Fundus photo, 45° FOV: 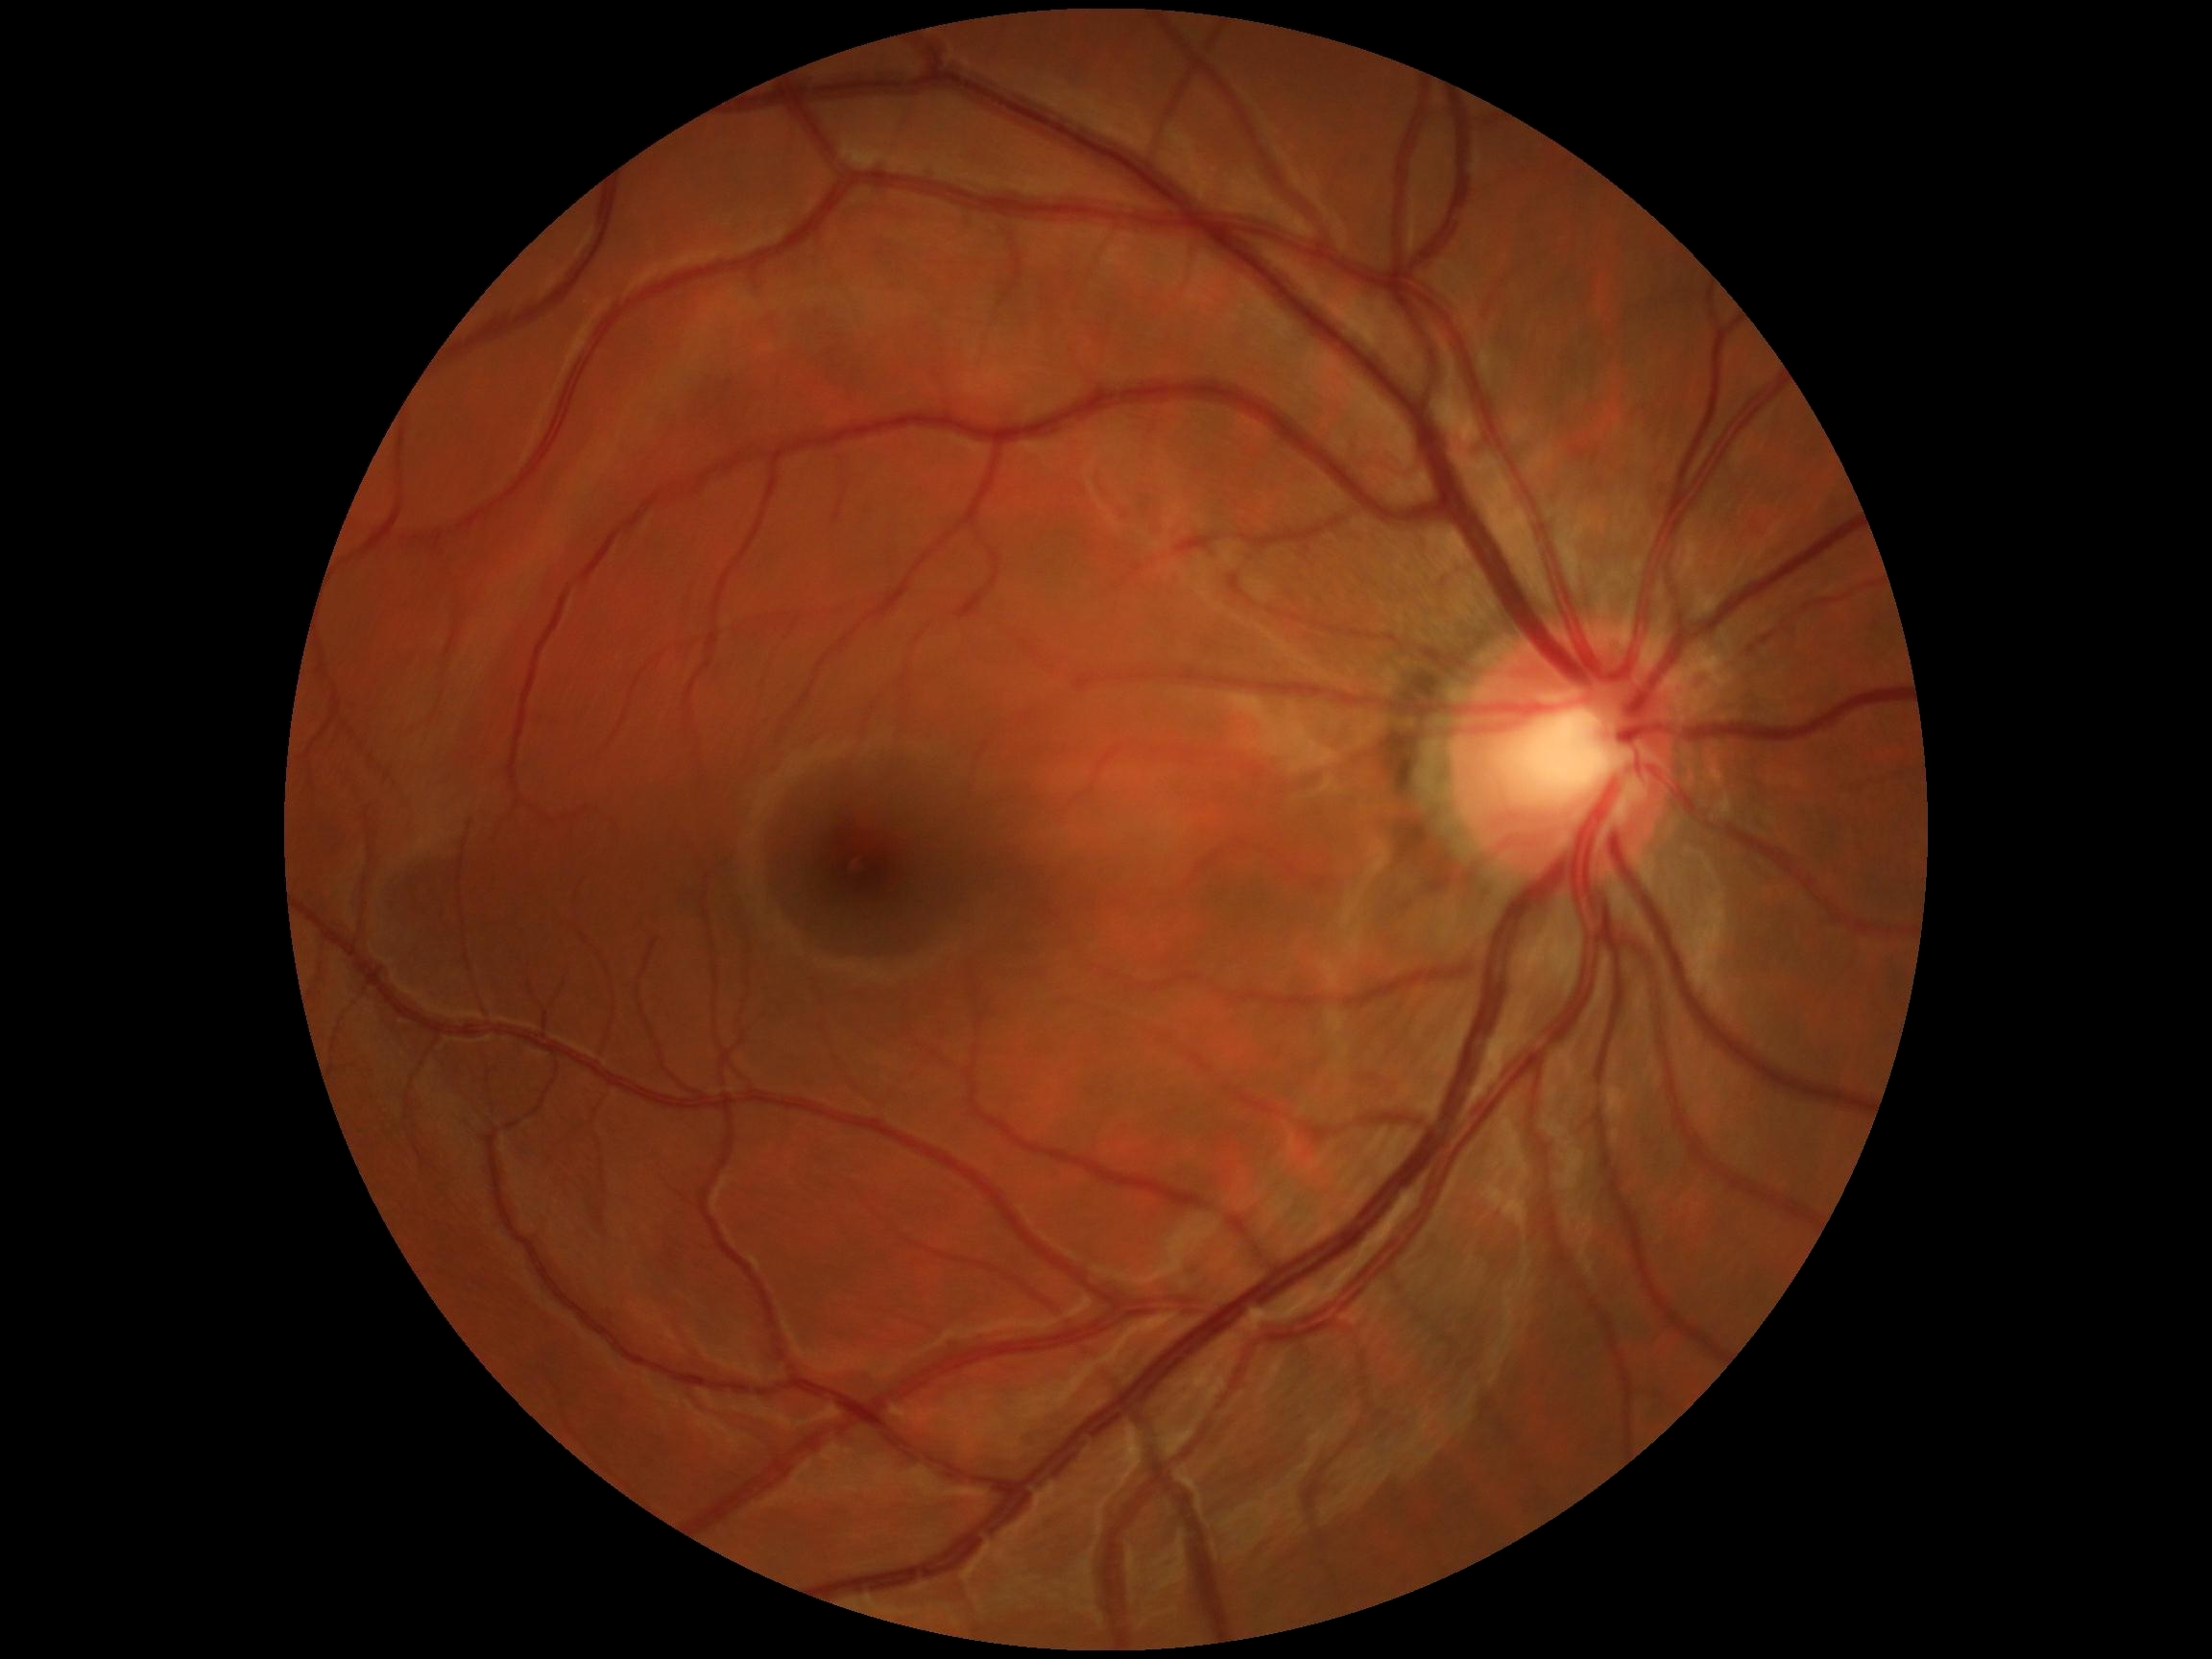 No DR findings. Diabetic retinopathy (DR): no apparent retinopathy (grade 0).